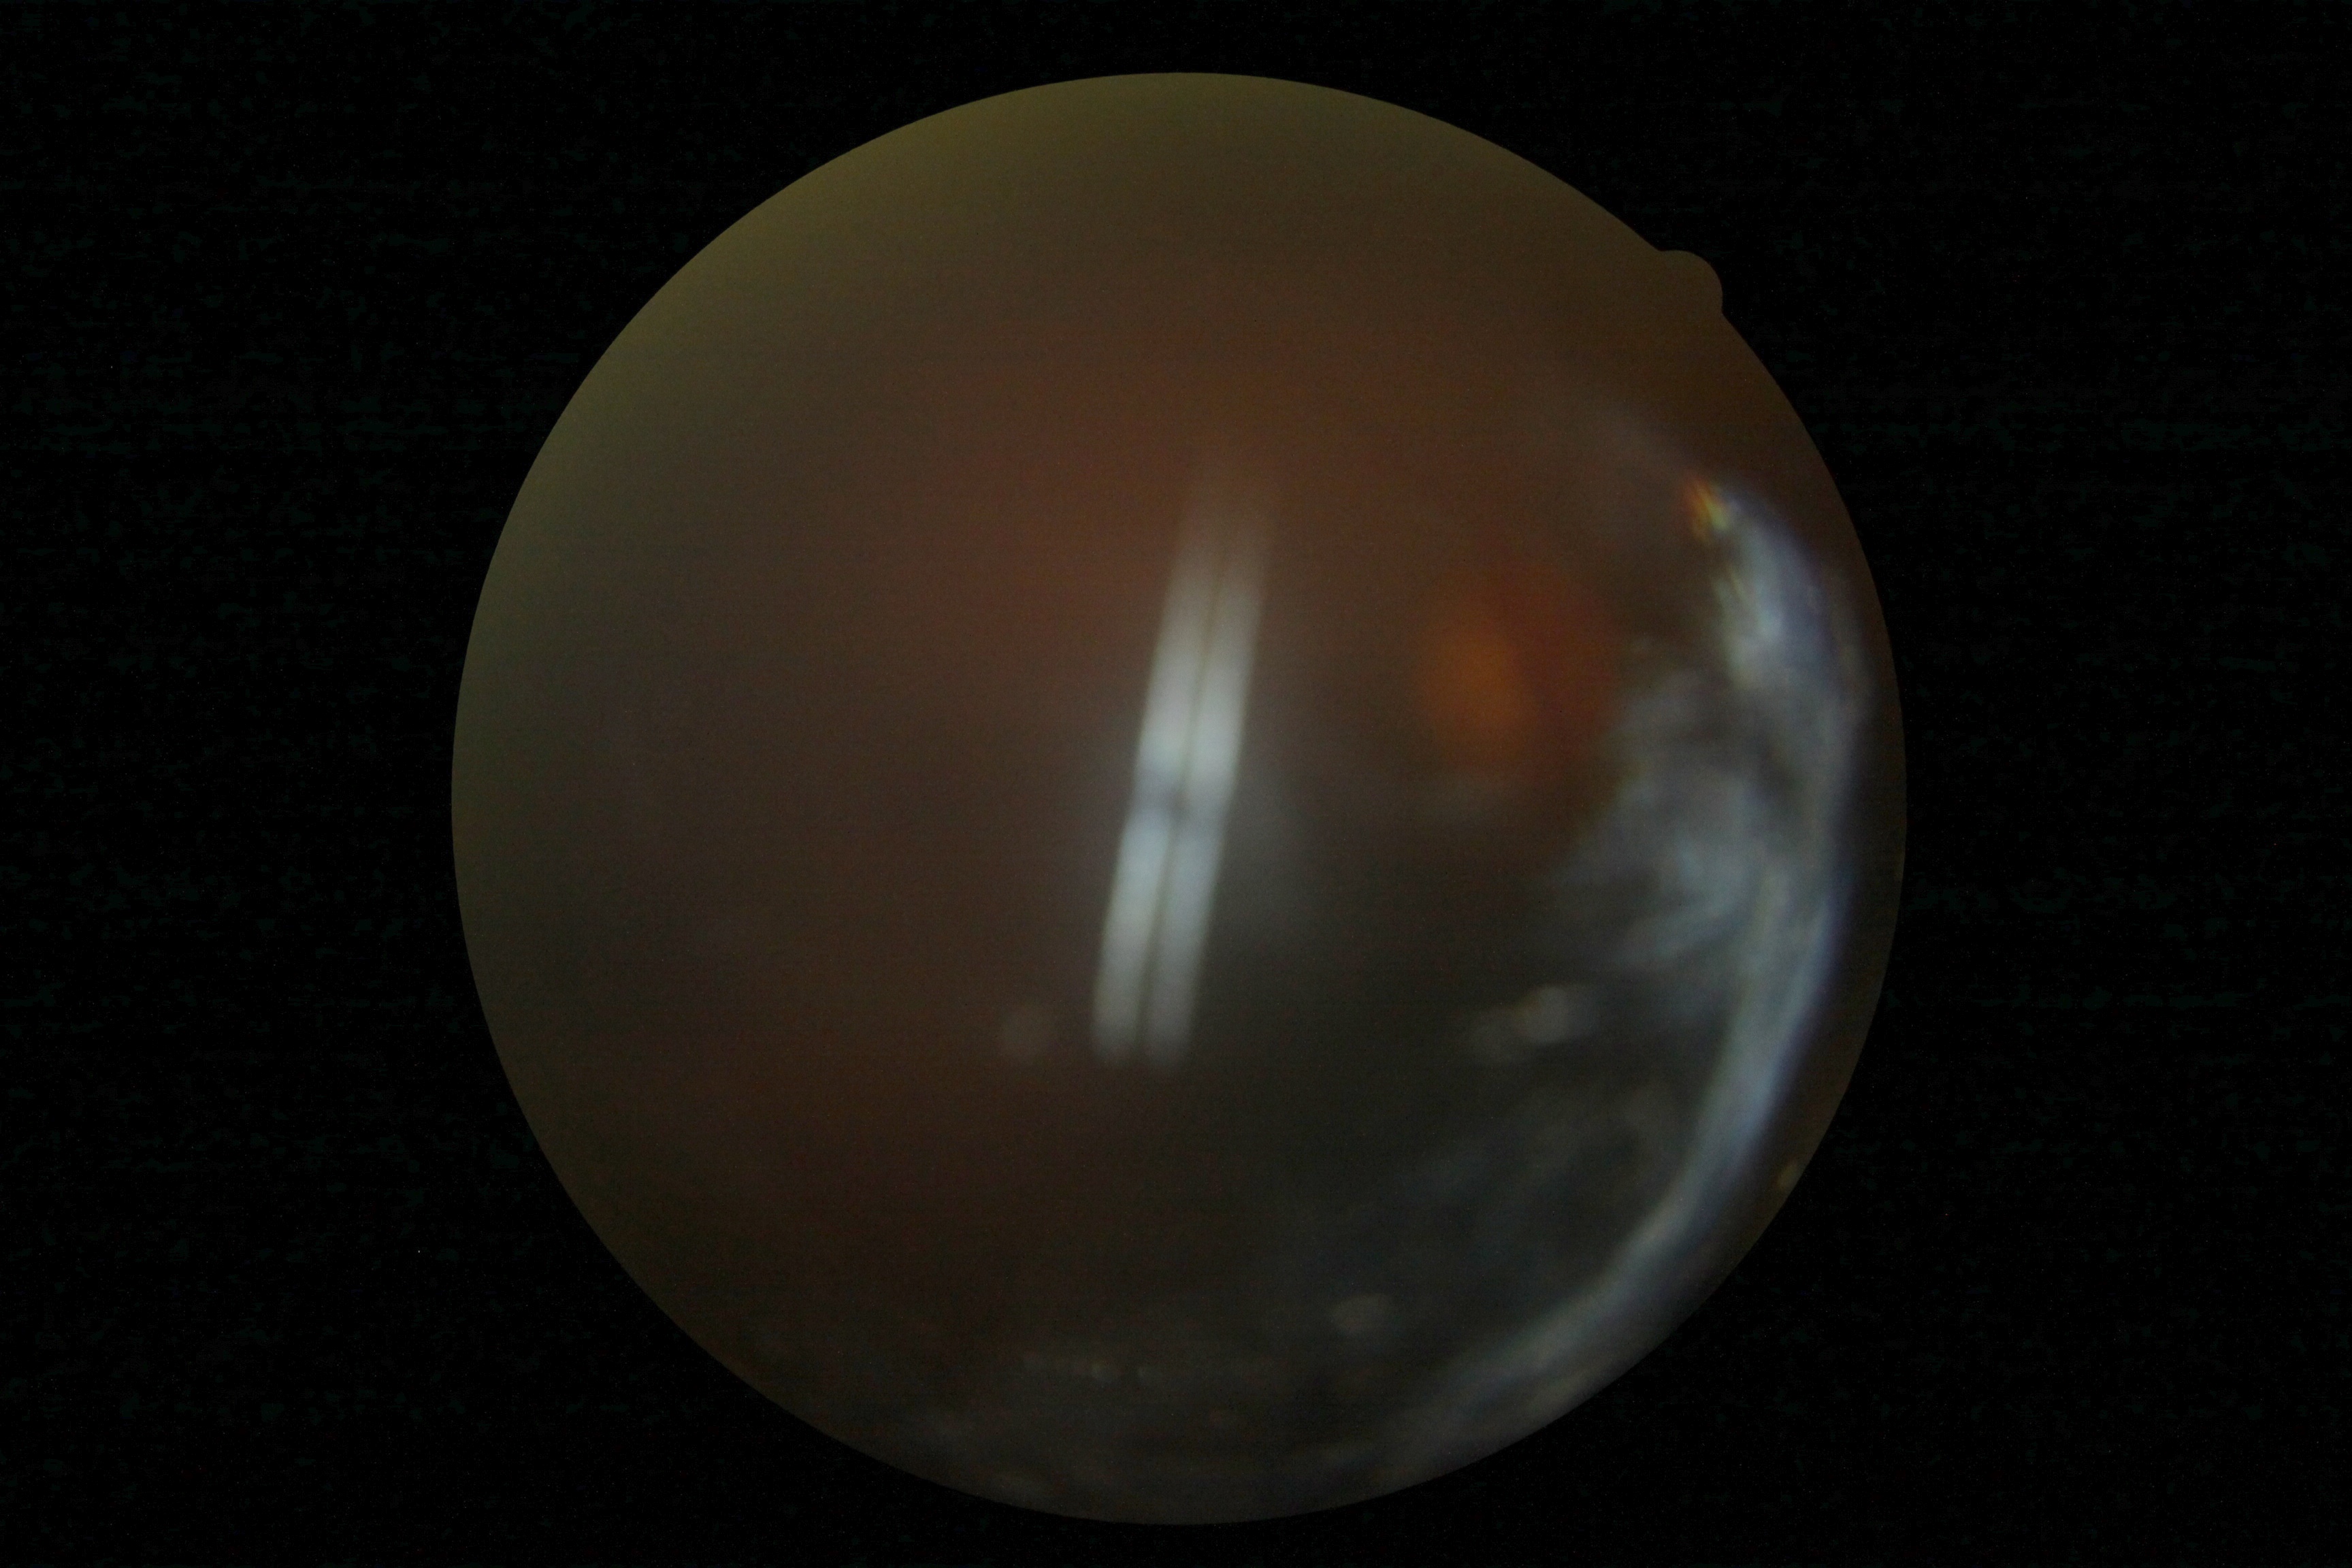

  dr_grade: ungradable due to poor image quality